2352x1568px; fundus photo; 45° field of view: 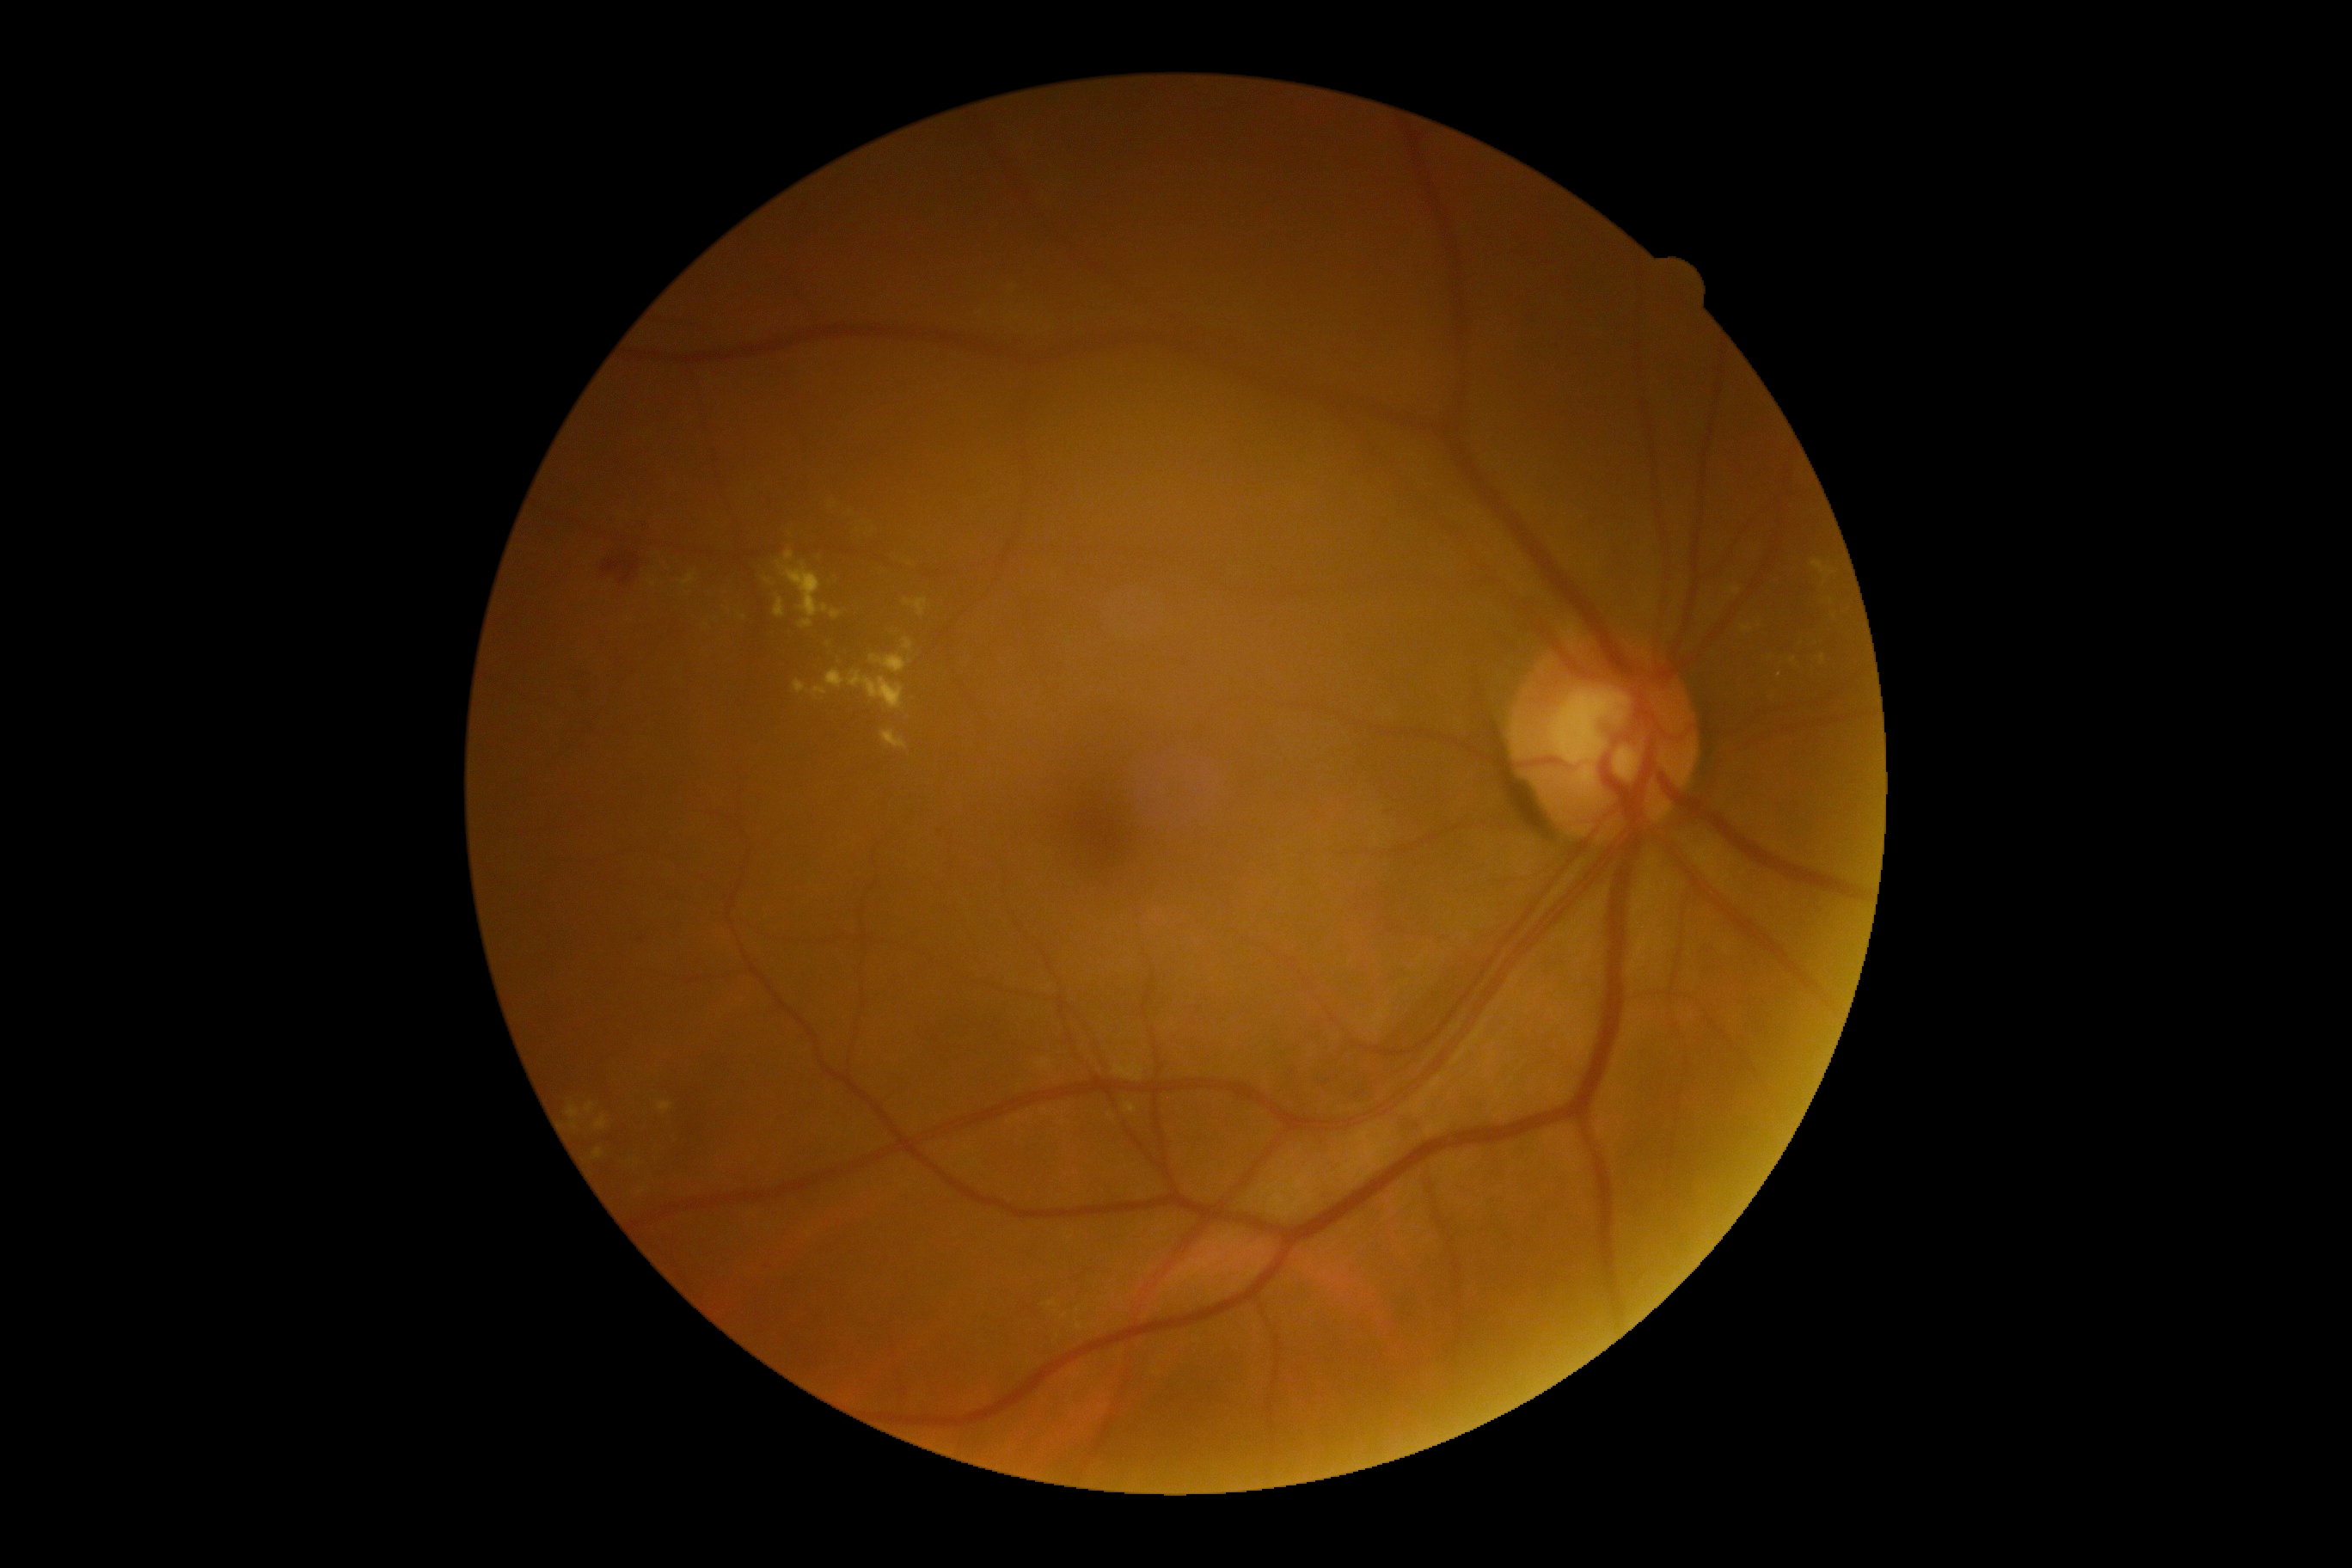
{"partial":true,"dr_grade":2,"lesions":{"ex":[[1739,618,1760,635],[596,1117,608,1129],[1113,1063,1144,1082],[1785,656,1796,666],[909,556,919,568],[881,732,907,749],[812,687,826,701],[1125,1103,1137,1115],[842,654,848,666],[567,1106,579,1120],[585,1103,594,1113],[1075,1323,1082,1332],[1046,1302,1058,1308],[848,671,905,711],[775,597,785,618]],"ex_small_approx":[[767,582],[1779,673],[1769,692]]}}